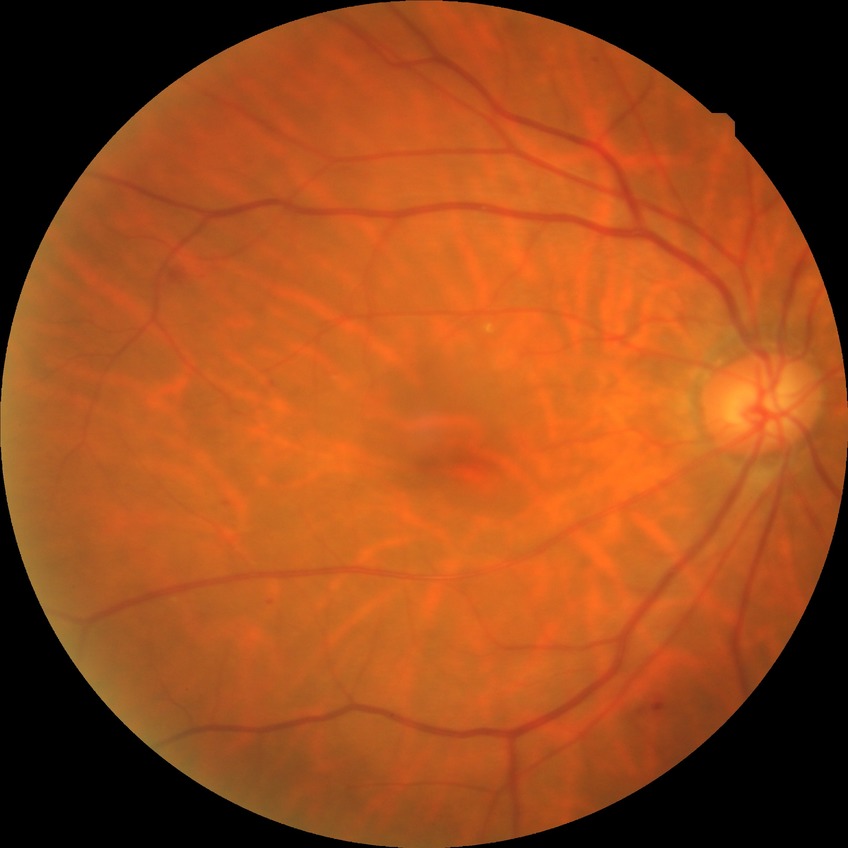

diabetic retinopathy (DR)=simple diabetic retinopathy (SDR).